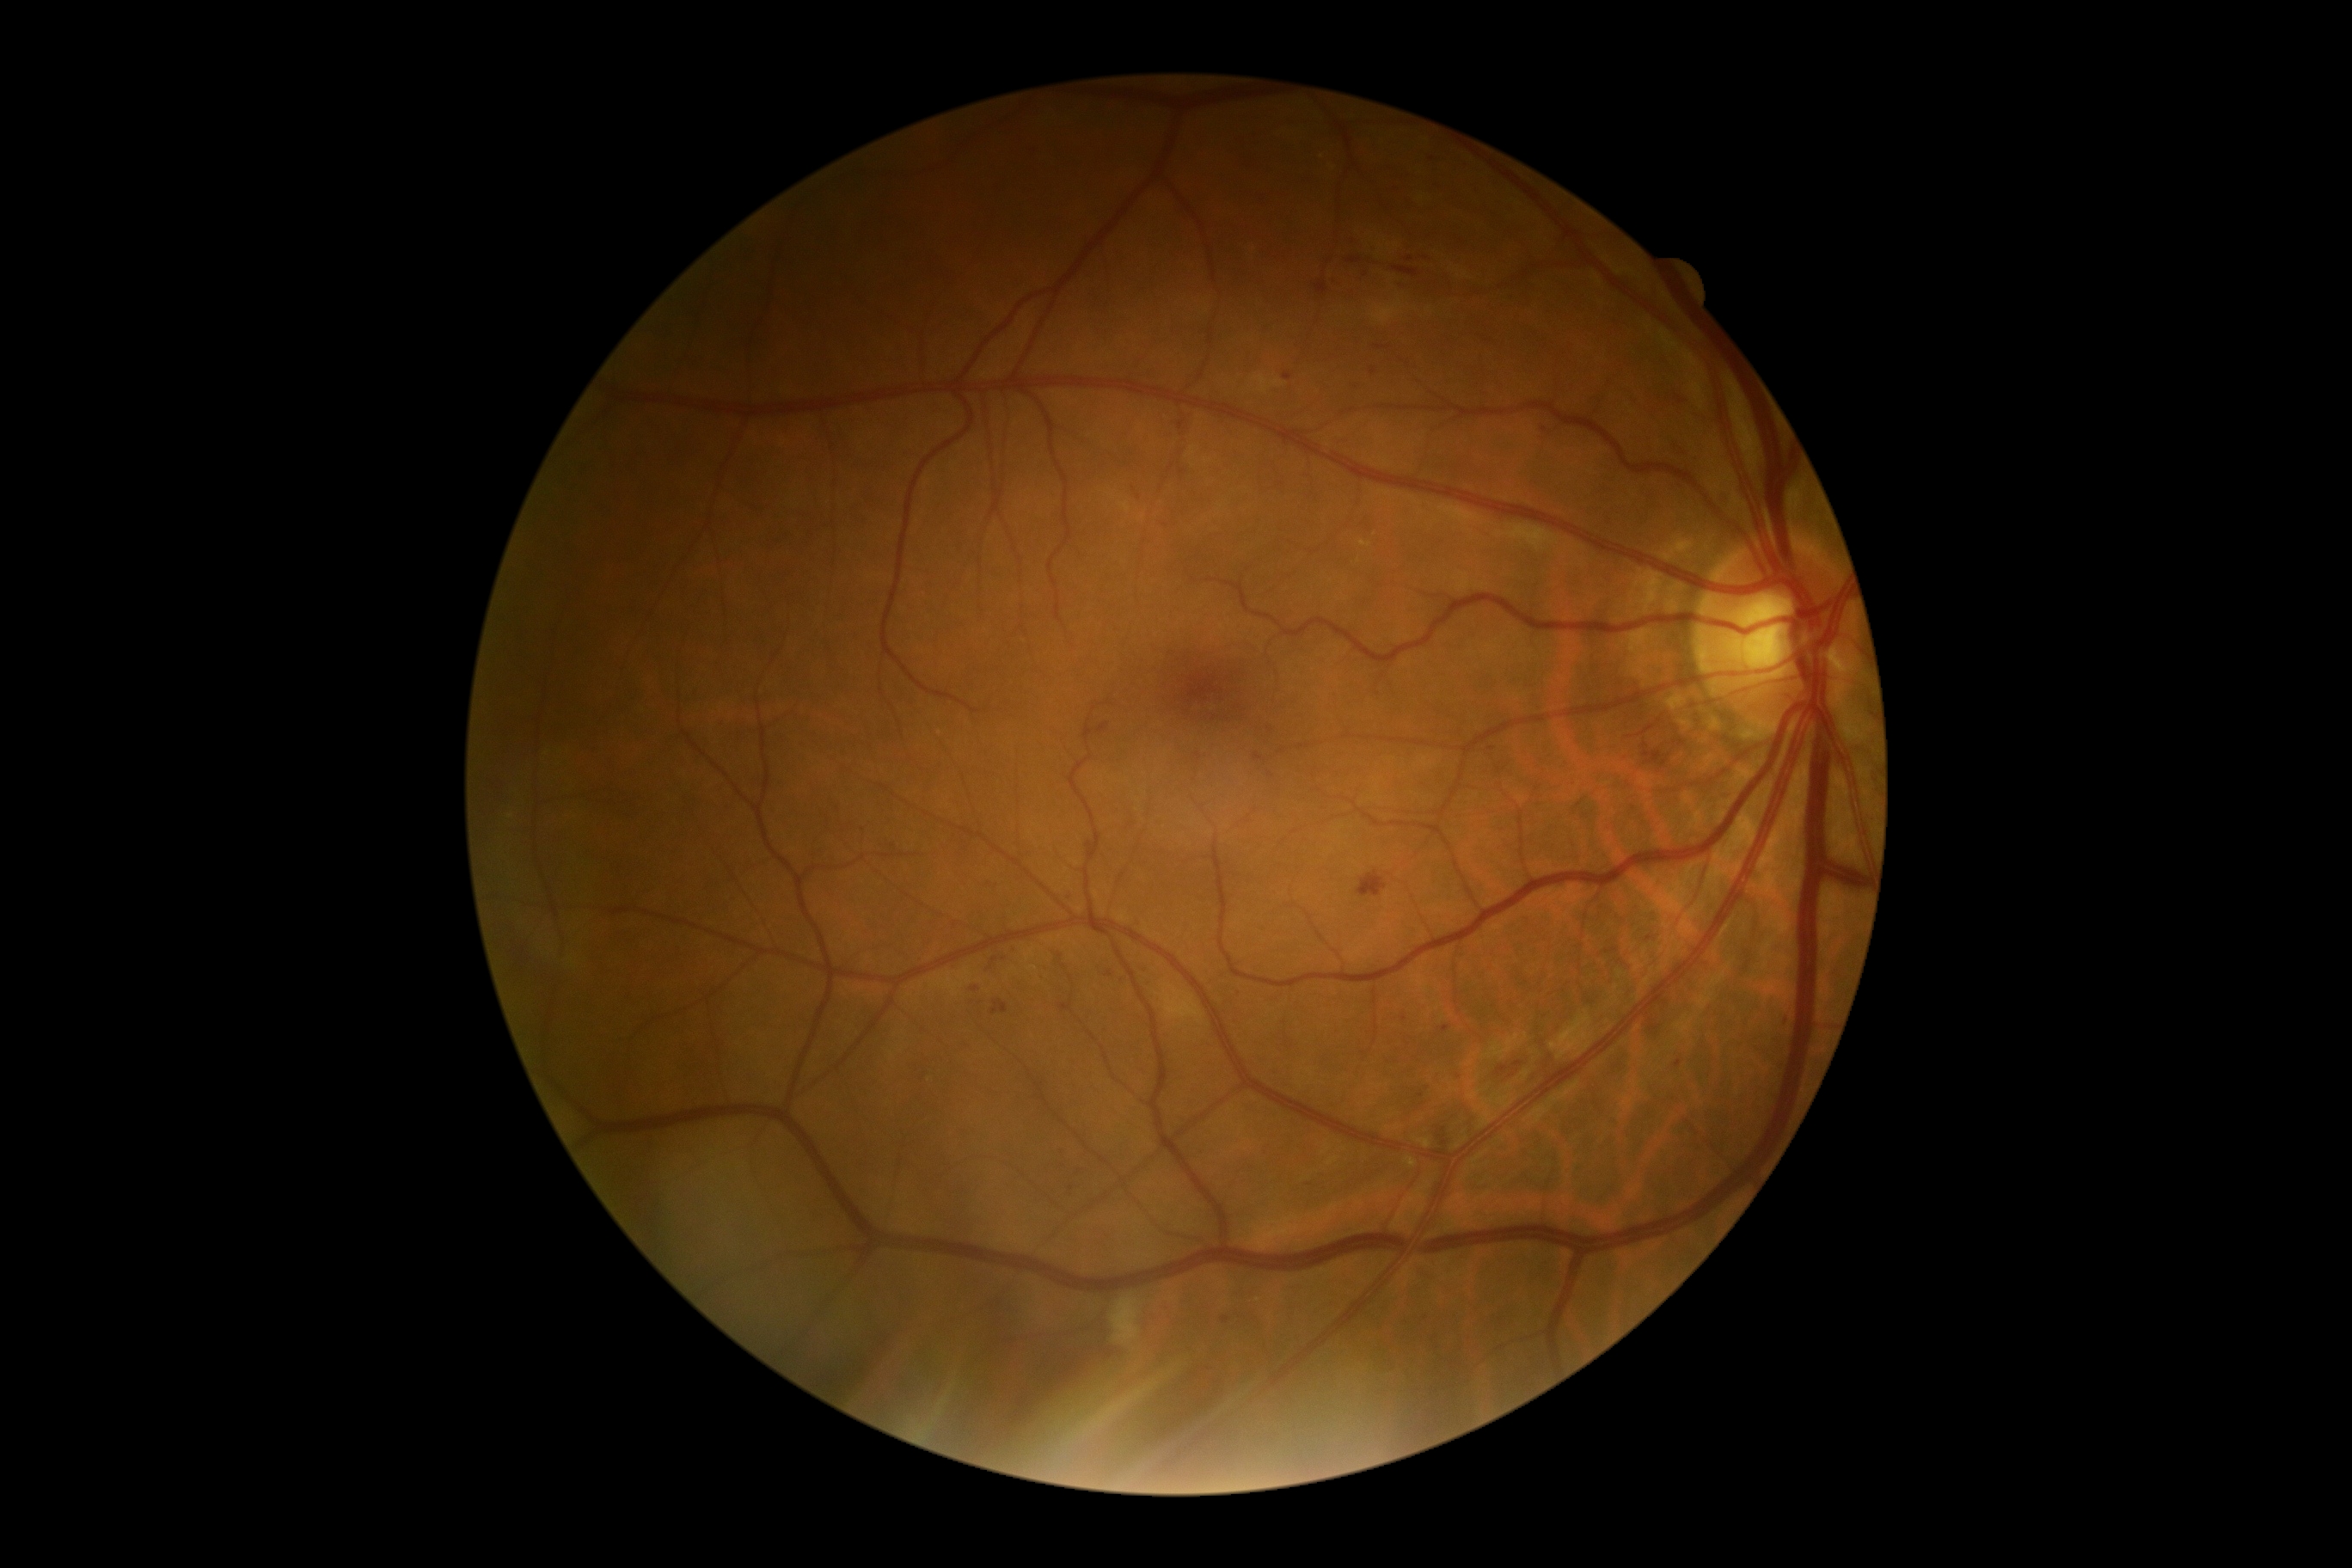 Diabetic retinopathy (DR) is grade 2 (moderate NPDR). Hemorrhages (HEs) found at <region>1648, 1019, 1660, 1034</region>; <region>1098, 723, 1110, 733</region>; <region>1646, 750, 1667, 759</region>; <region>1605, 948, 1619, 955</region>; <region>1357, 871, 1388, 897</region>; <region>1347, 257, 1363, 264</region>; <region>1082, 847, 1094, 859</region>; <region>1136, 491, 1141, 499</region>; <region>1435, 1137, 1452, 1153</region>; <region>1502, 1069, 1521, 1084</region>; <region>991, 1000, 1008, 1015</region>; <region>1393, 267, 1419, 278</region>; <region>1675, 444, 1687, 453</region>; <region>1182, 419, 1189, 436</region>; <region>1713, 498, 1730, 510</region>. Small HEs approximately at 1681:402. Soft exudates (SEs) found at <region>1112, 1297, 1141, 1347</region>. Microaneurysms (MAs) are present, including at <region>1139, 967, 1148, 971</region>; <region>1316, 283, 1328, 295</region>; <region>1406, 257, 1414, 262</region>; <region>1283, 372, 1292, 383</region>; <region>1354, 383, 1361, 391</region>; <region>1347, 235, 1357, 245</region>; <region>1055, 950, 1065, 957</region>. Small MAs approximately at 1373:373; 1545:430; 1365:274; 1421:1096; 1072:899; 1271:730; 975:990. Hard exudates (EXs) are present, including at <region>1361, 541, 1371, 548</region>. Small EXs approximately at 1323:157.